1932 x 1932 pixels. 45° FOV:
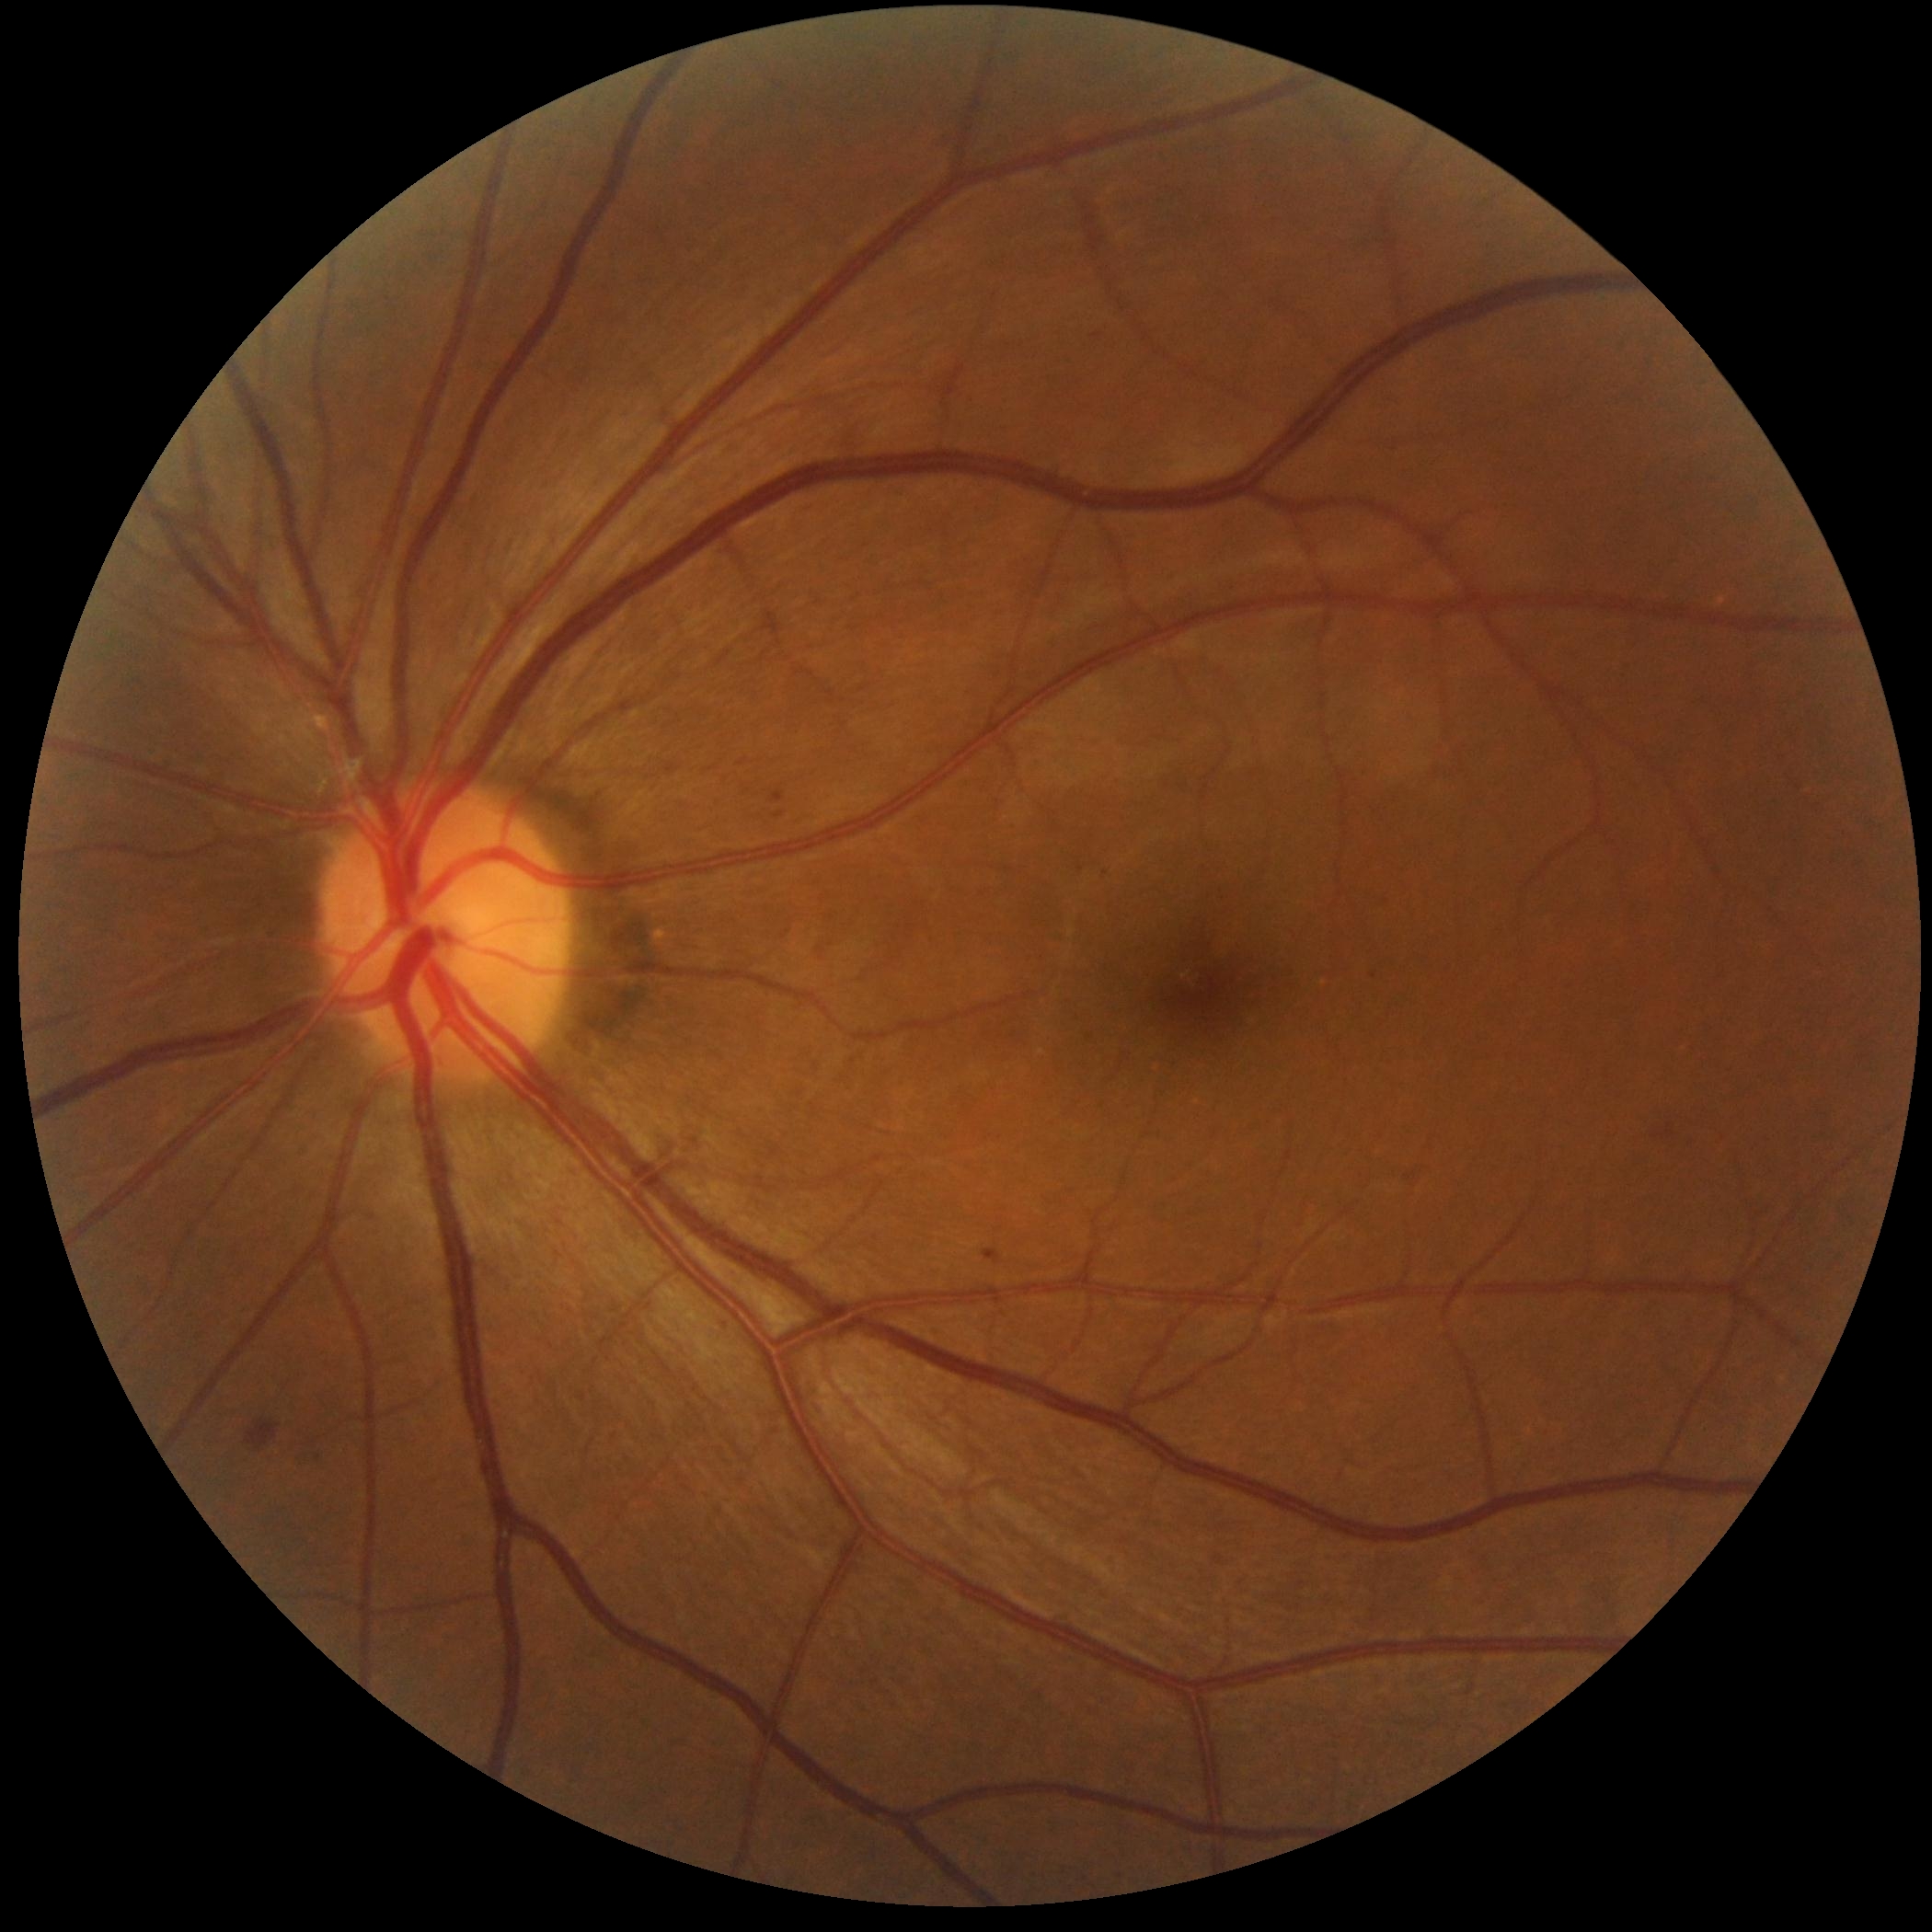 Disease class: non-proliferative diabetic retinopathy. Retinopathy: 2.